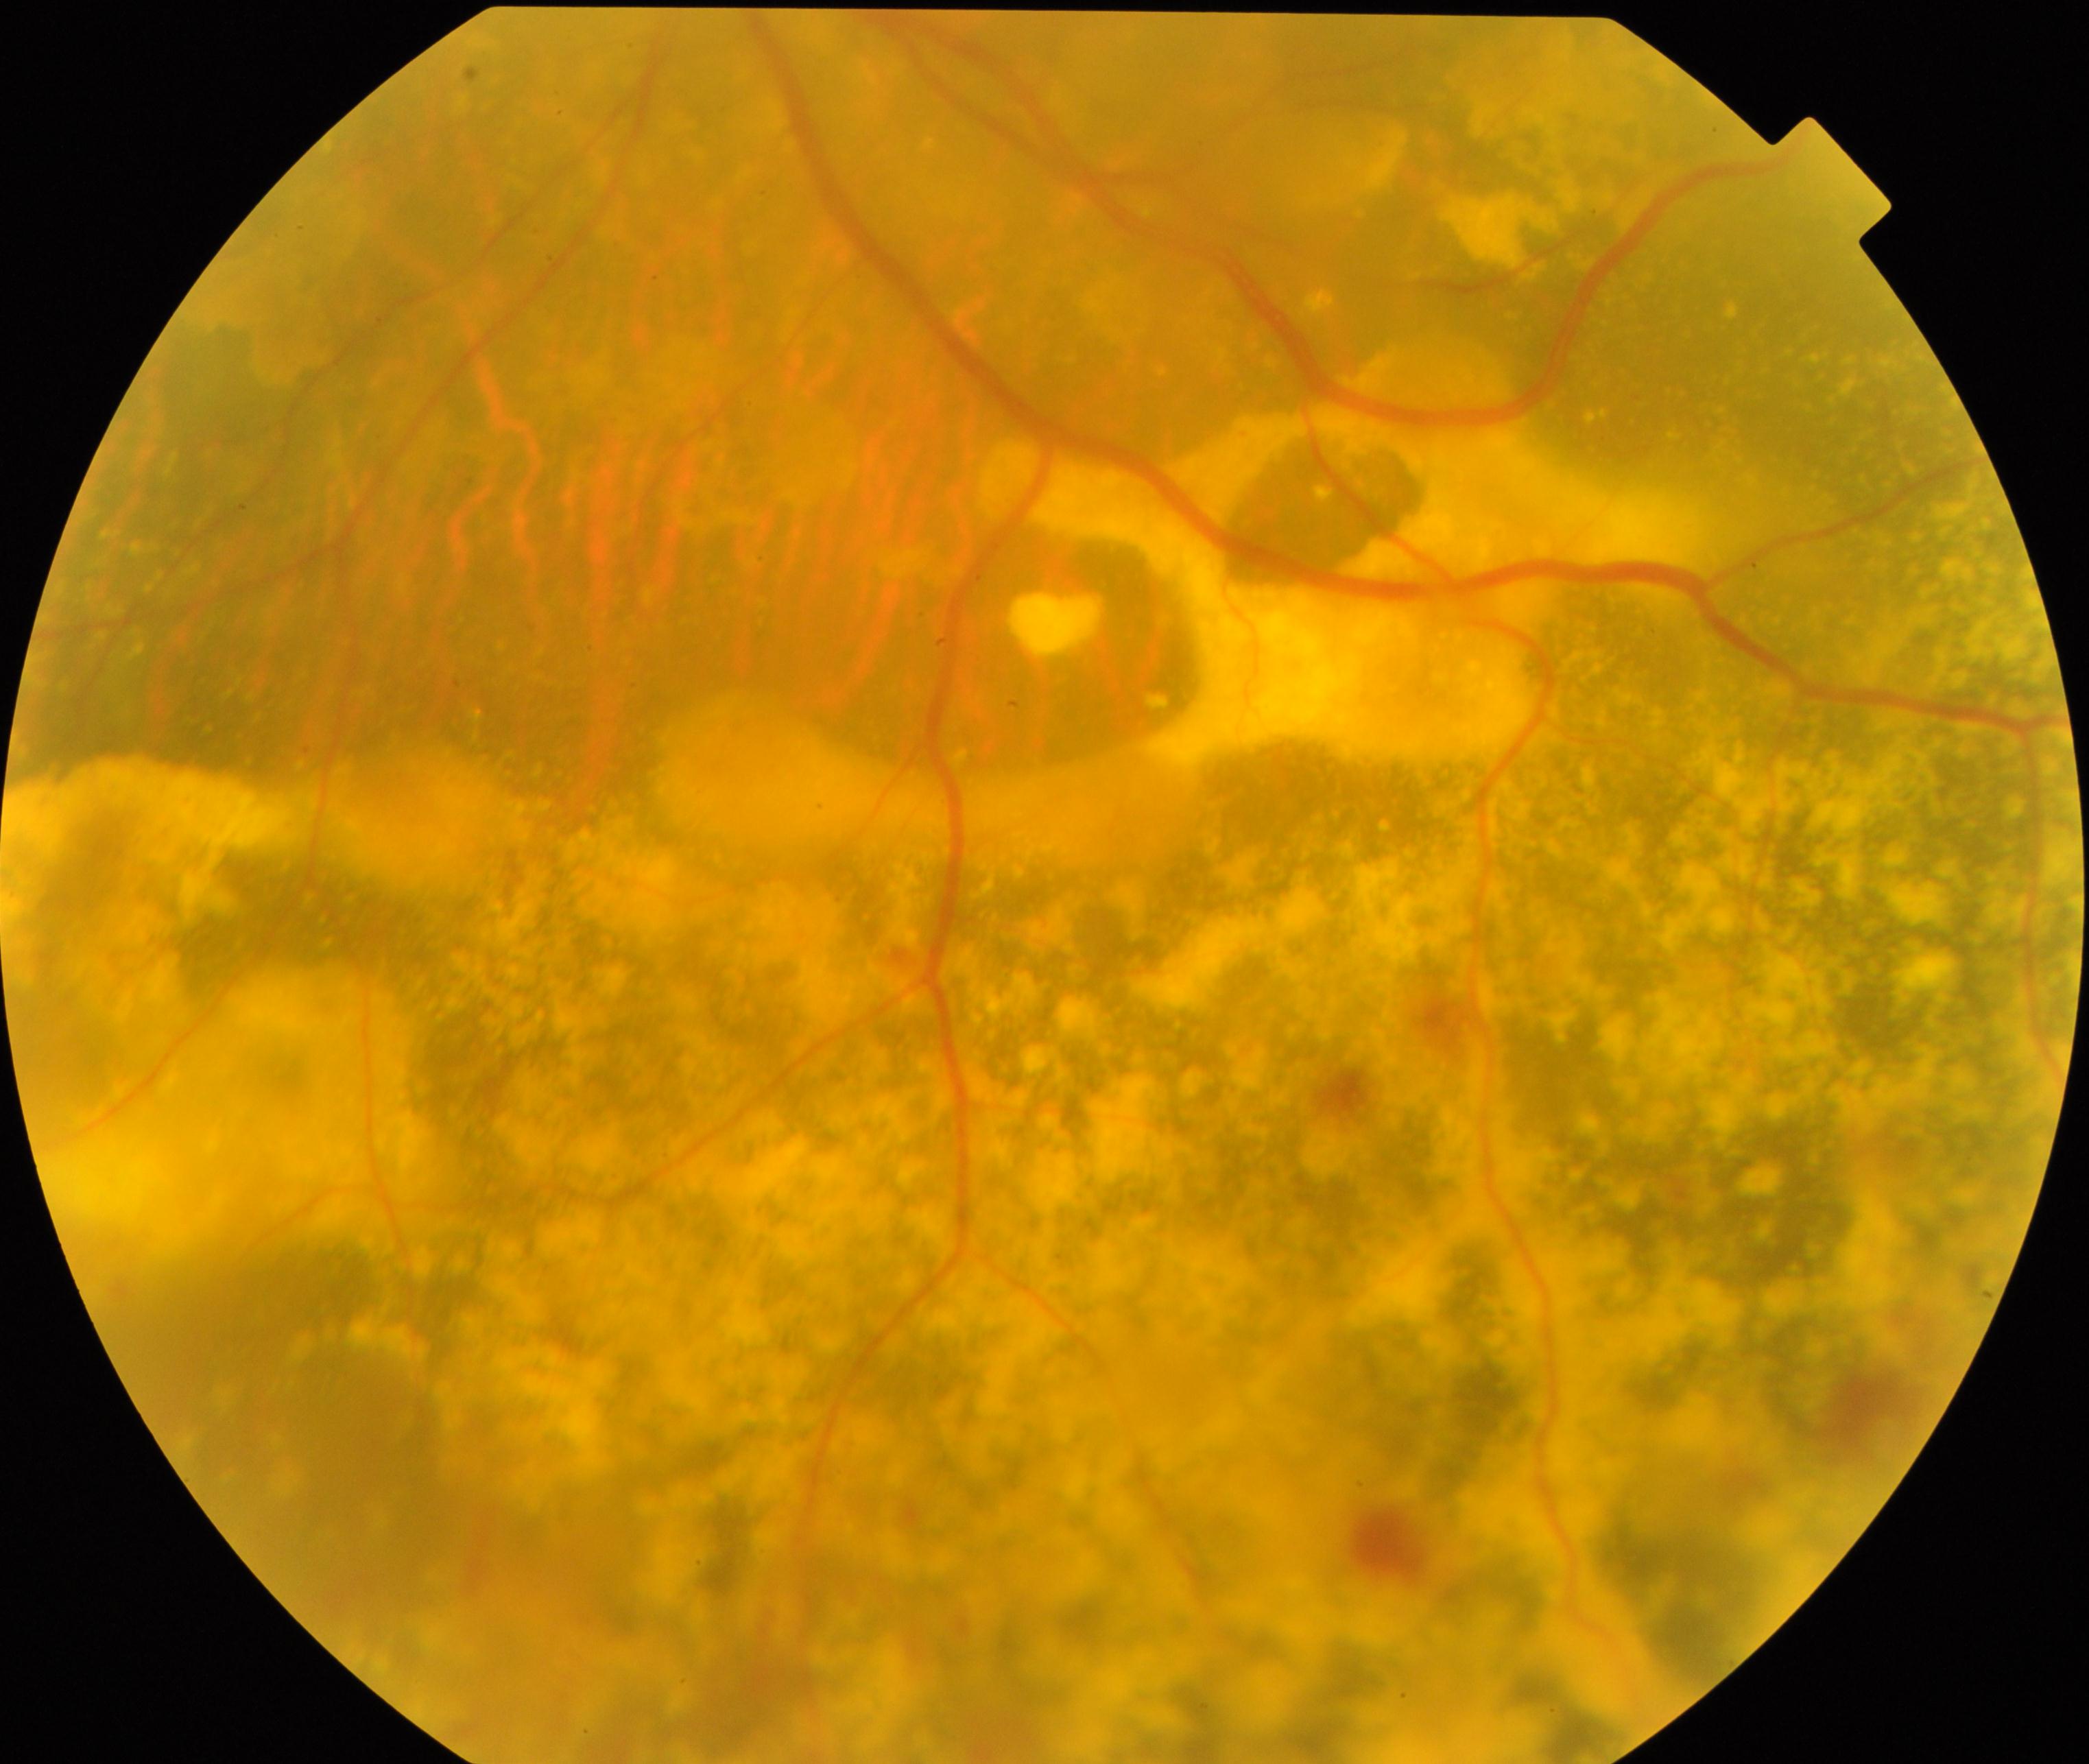
Diagnosis: massive hard exudates.